45° FOV — 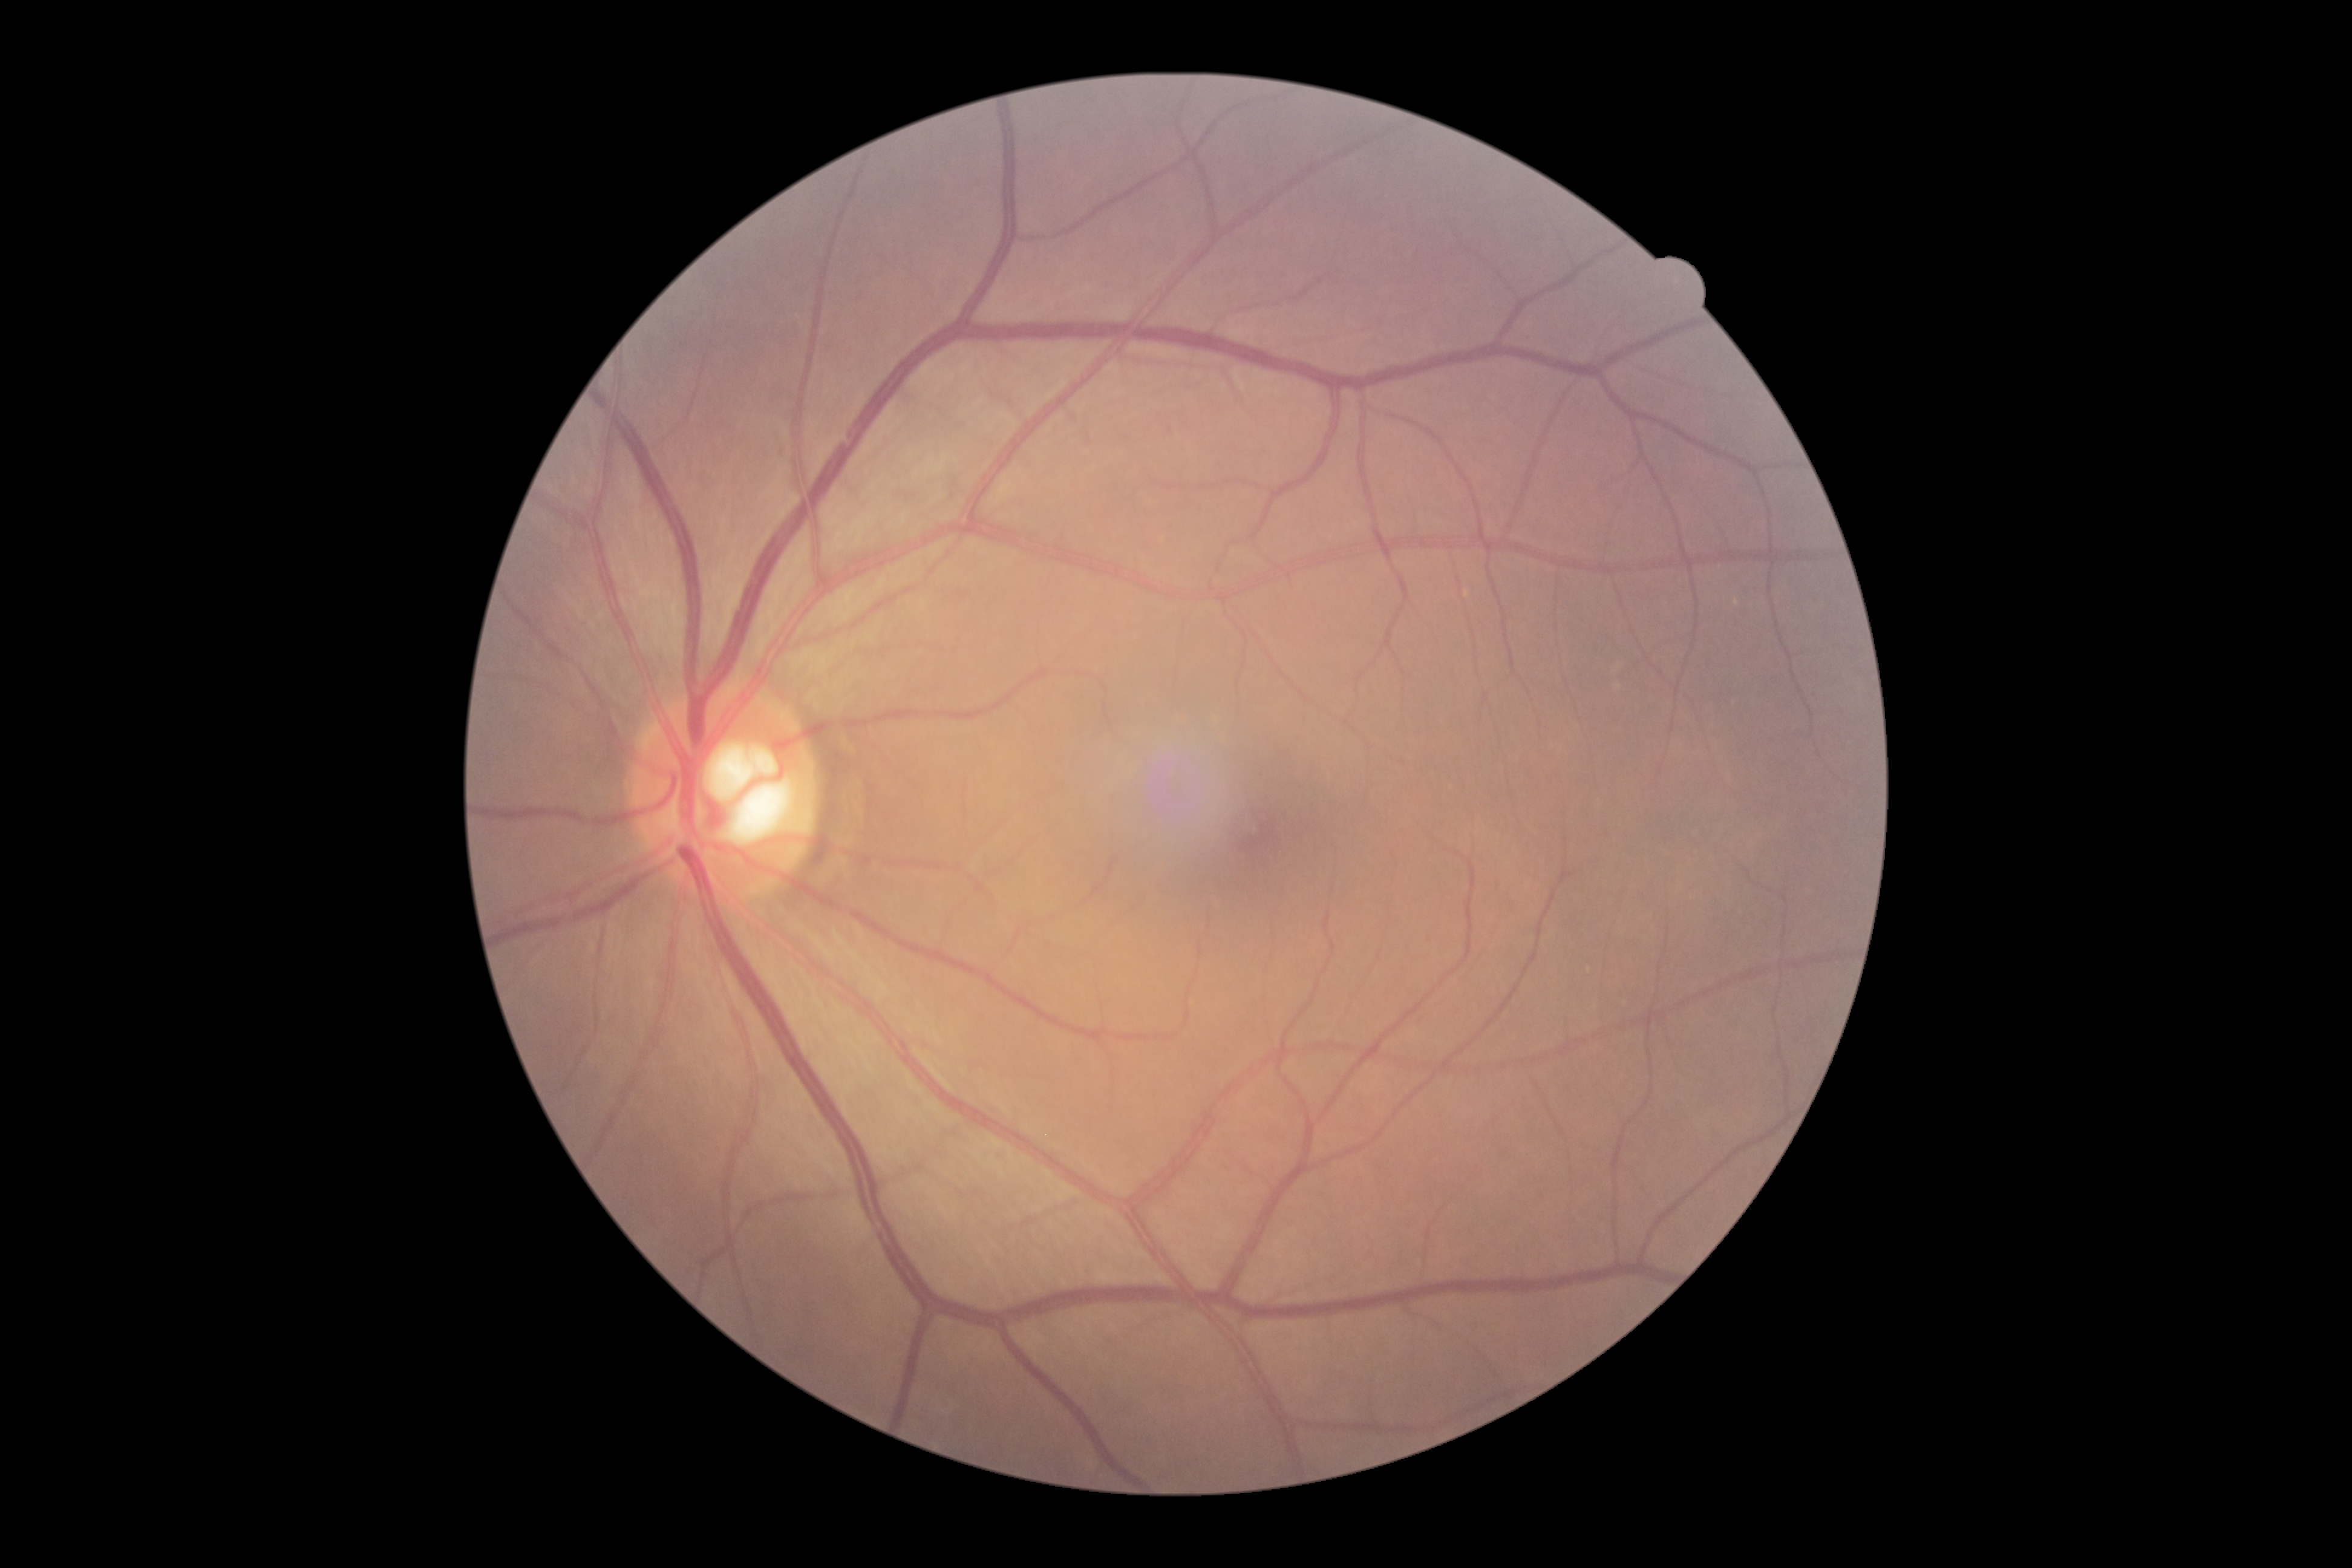
DR grade = no apparent diabetic retinopathy (0) | DR impression = no signs of DR.